RetCam wide-field infant fundus image
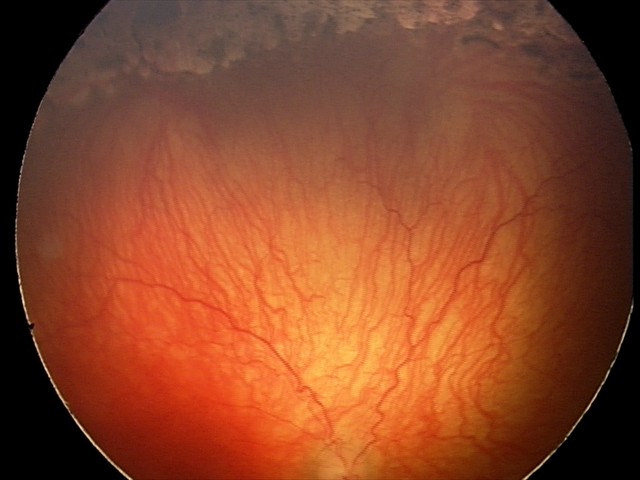

Q: What is the diagnosis from this examination?
A: A-ROP (aggressive ROP) — rapidly progressive severe ROP with prominent plus disease, often without classic stage progression